Wide-field fundus photograph of an infant:
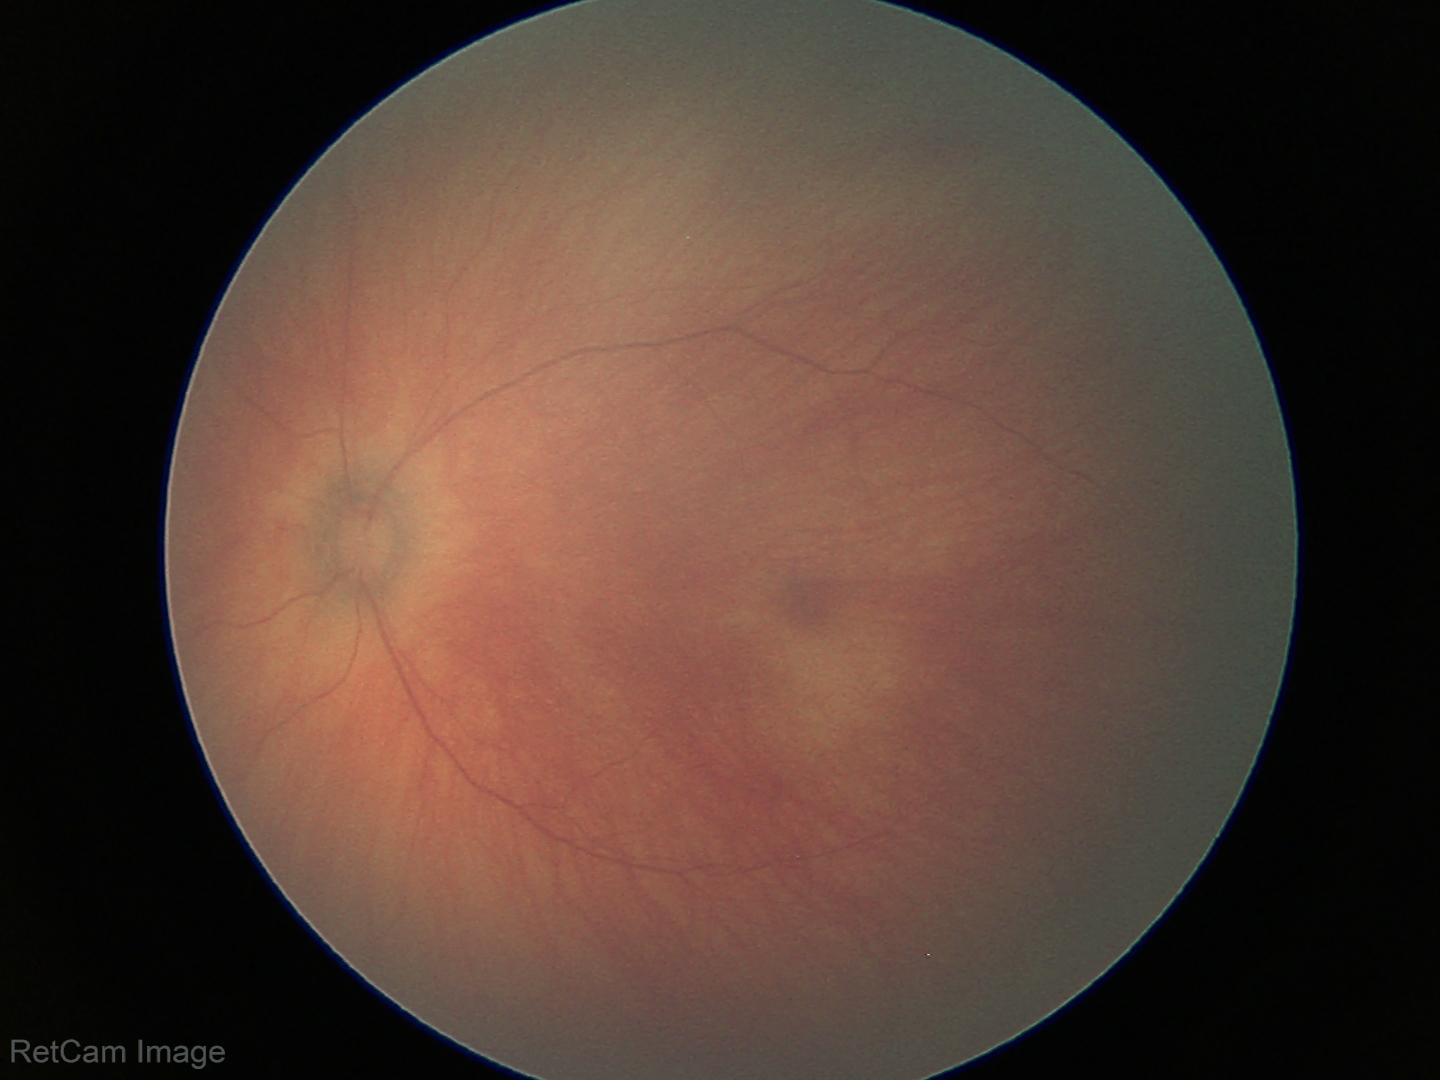 Examination with physiological retinal findings.